Modified Davis classification: 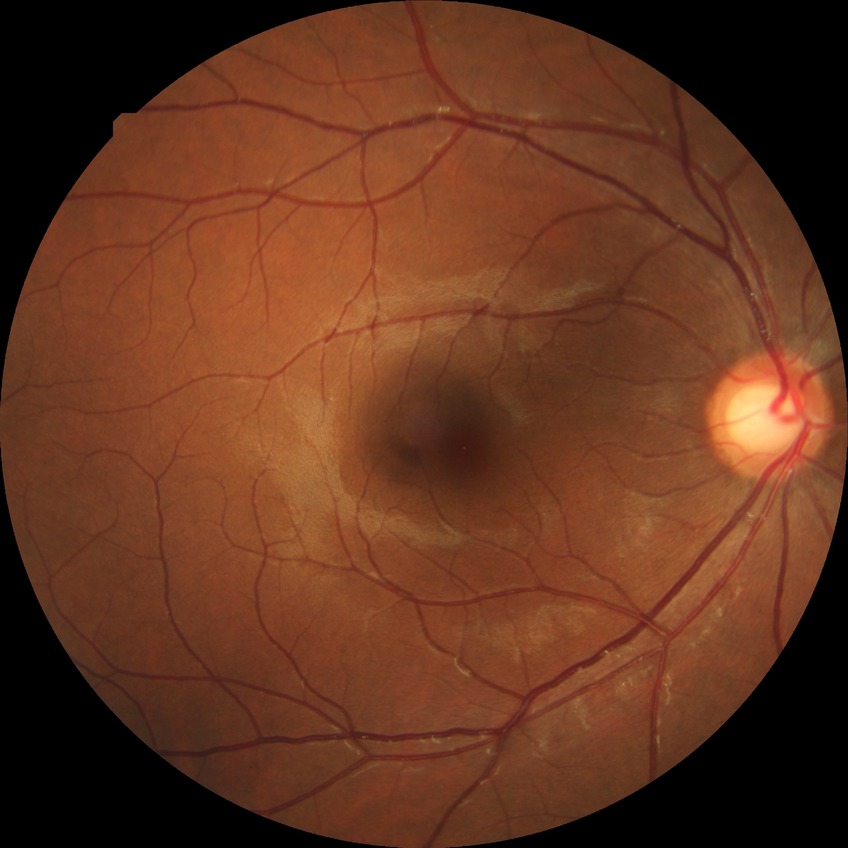

Diabetic retinopathy stage: no diabetic retinopathy.